Axial length 23.8 mm; central corneal thickness 488 µm; intraocular pressure 13 mmHg by applanation tonometry.
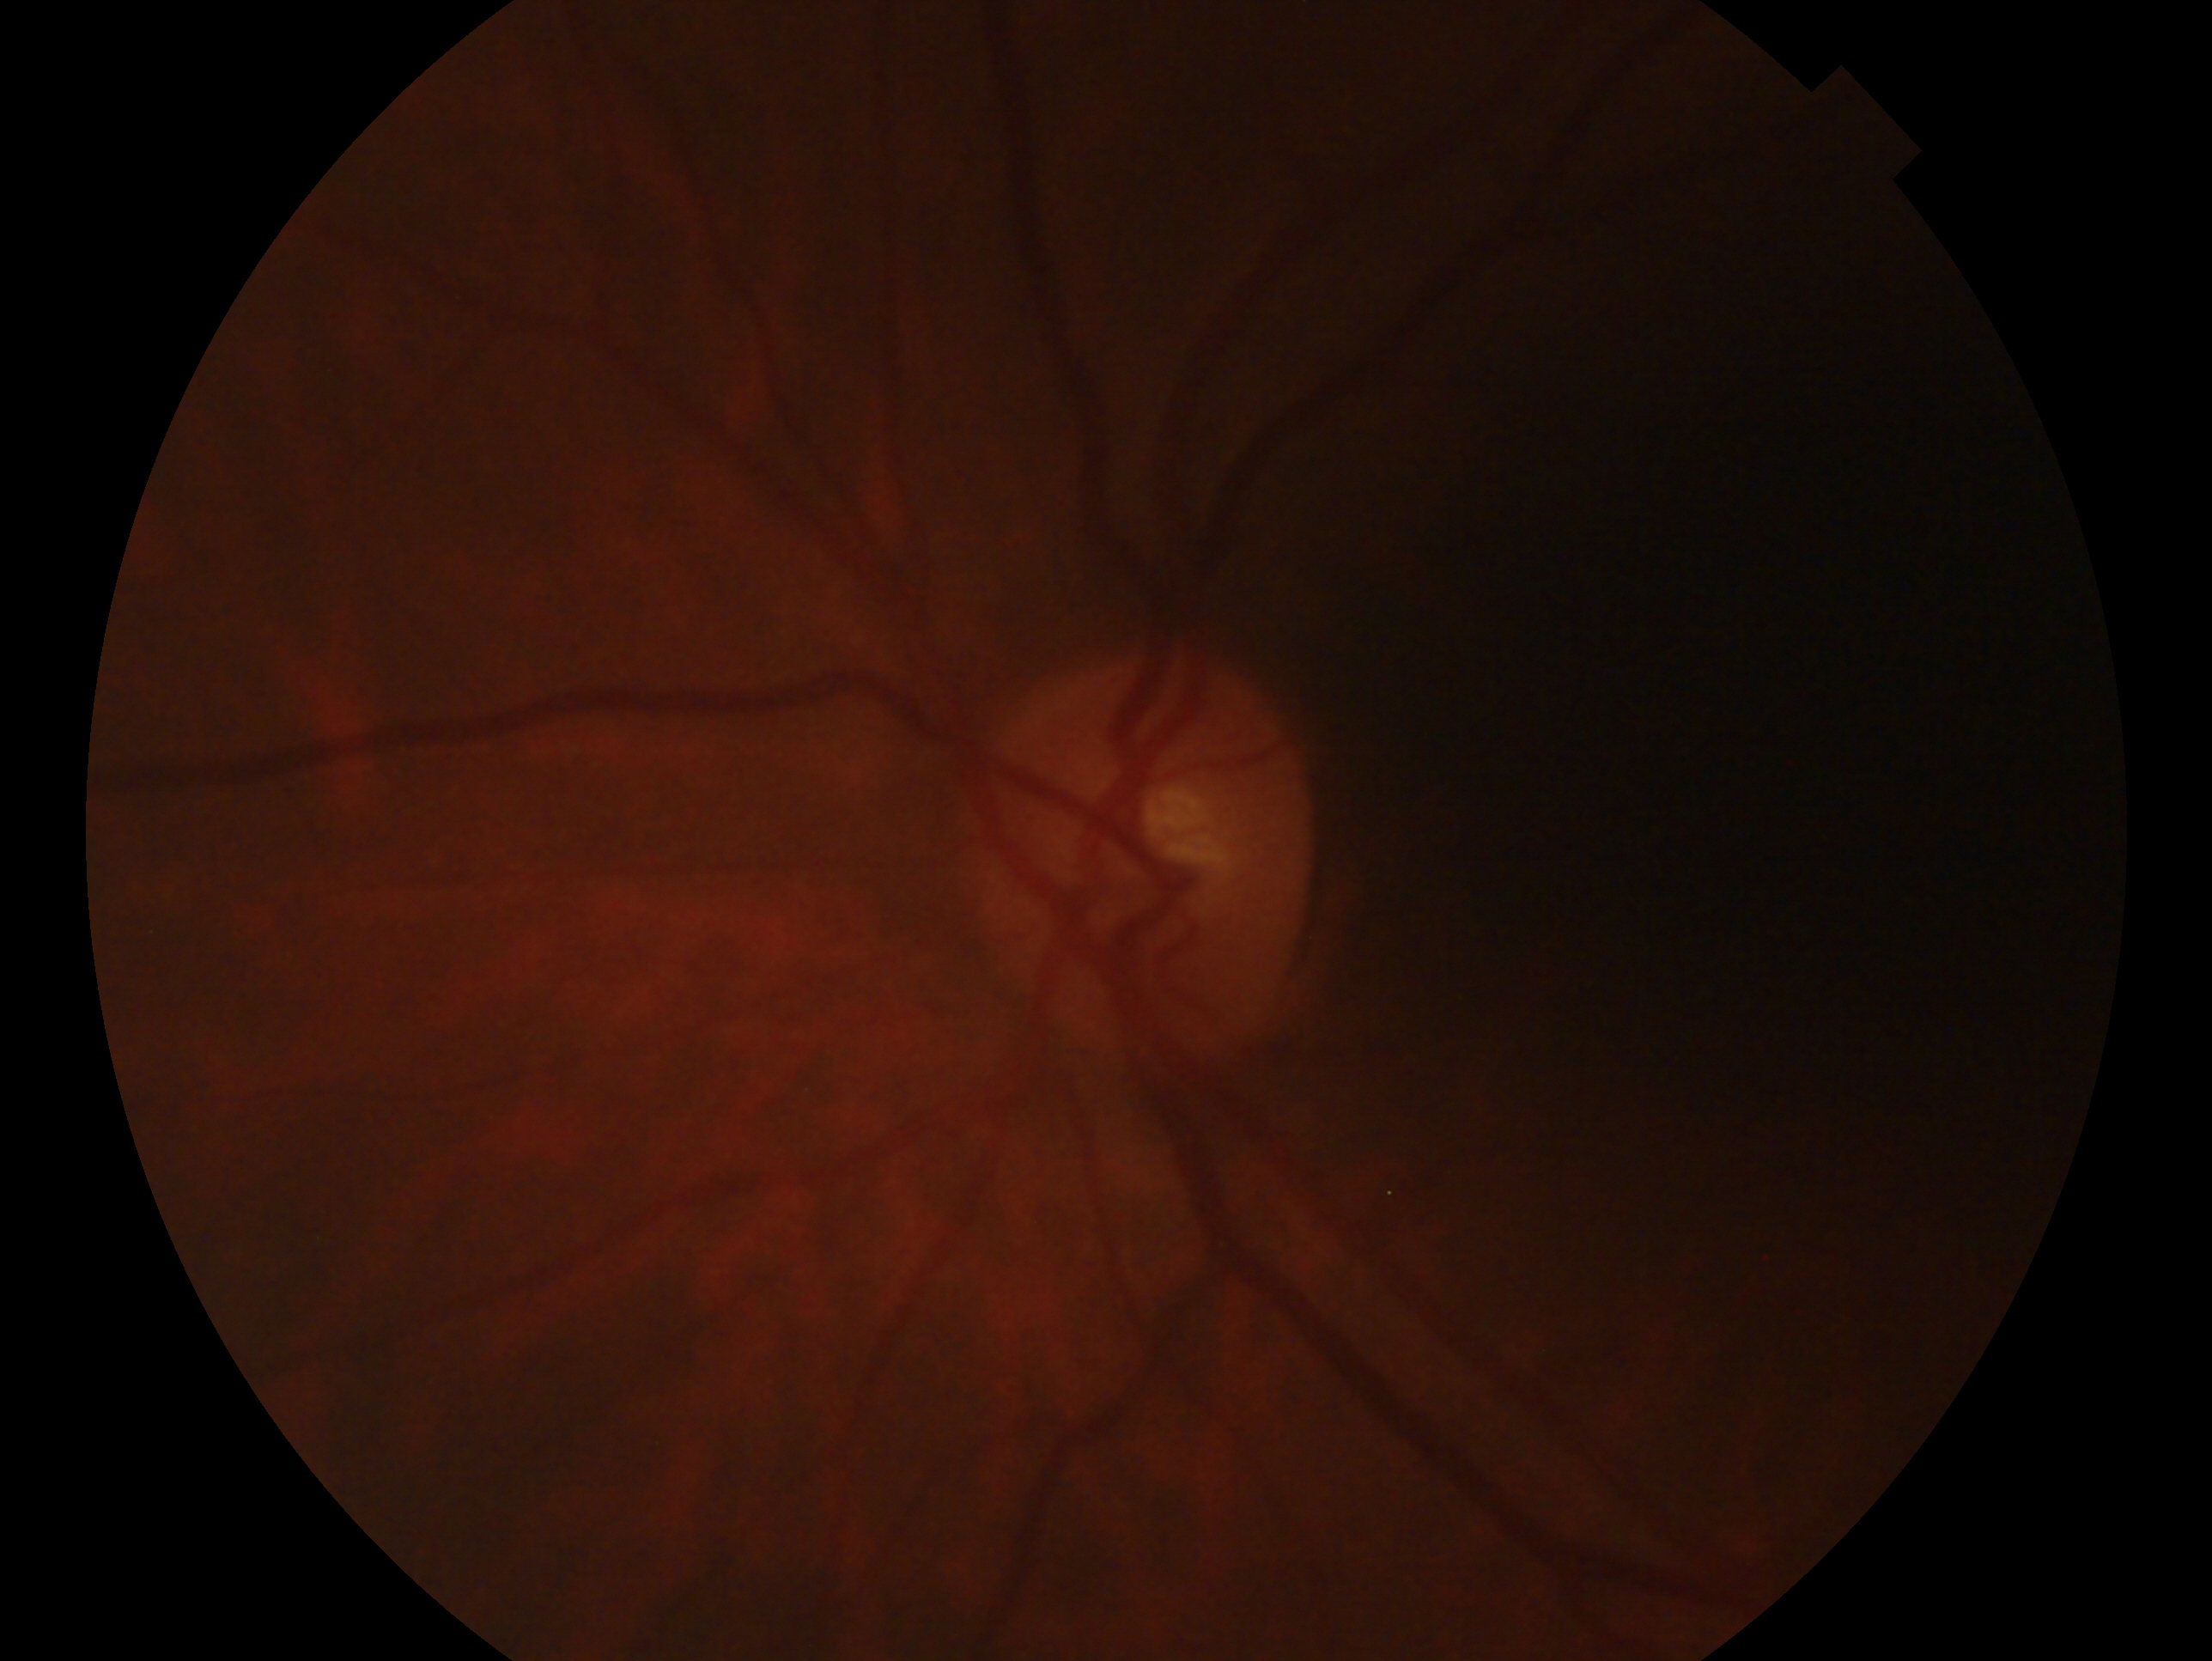

Glaucoma status: suspected glaucoma. Eye: OS.